Graded on the modified Davis scale; 848 x 848 pixels; NIDEK AFC-230 fundus camera; color fundus photograph.
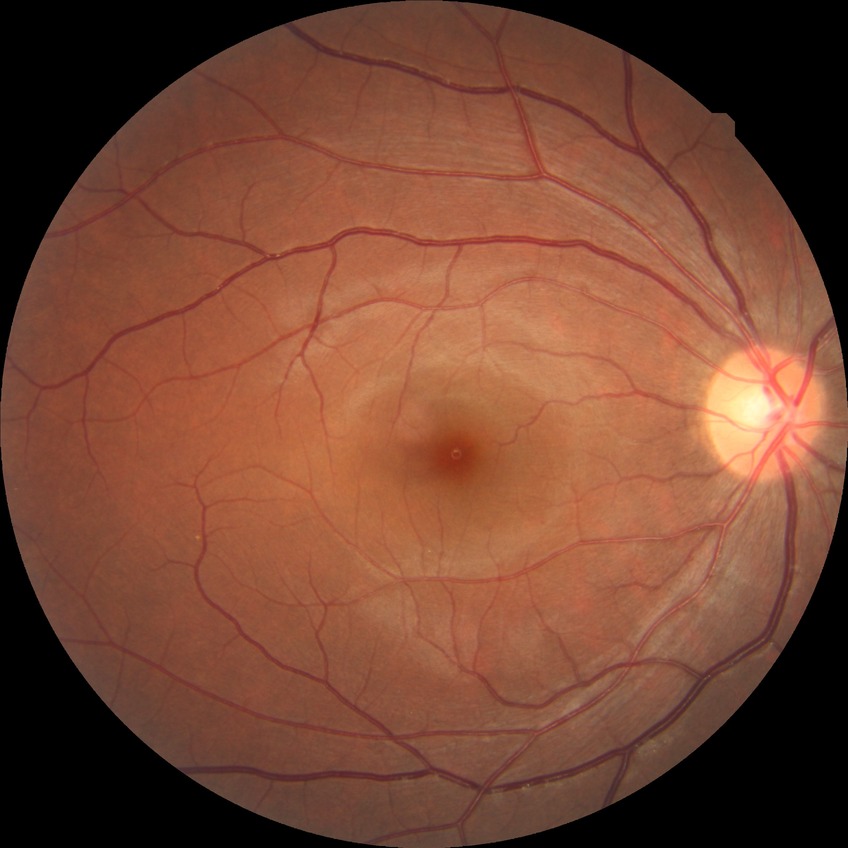

Diabetic retinopathy (DR): NDR (no diabetic retinopathy).